NIDEK AFC-230. 848 by 848 pixels. 45 degree fundus photograph. No pharmacologic dilation
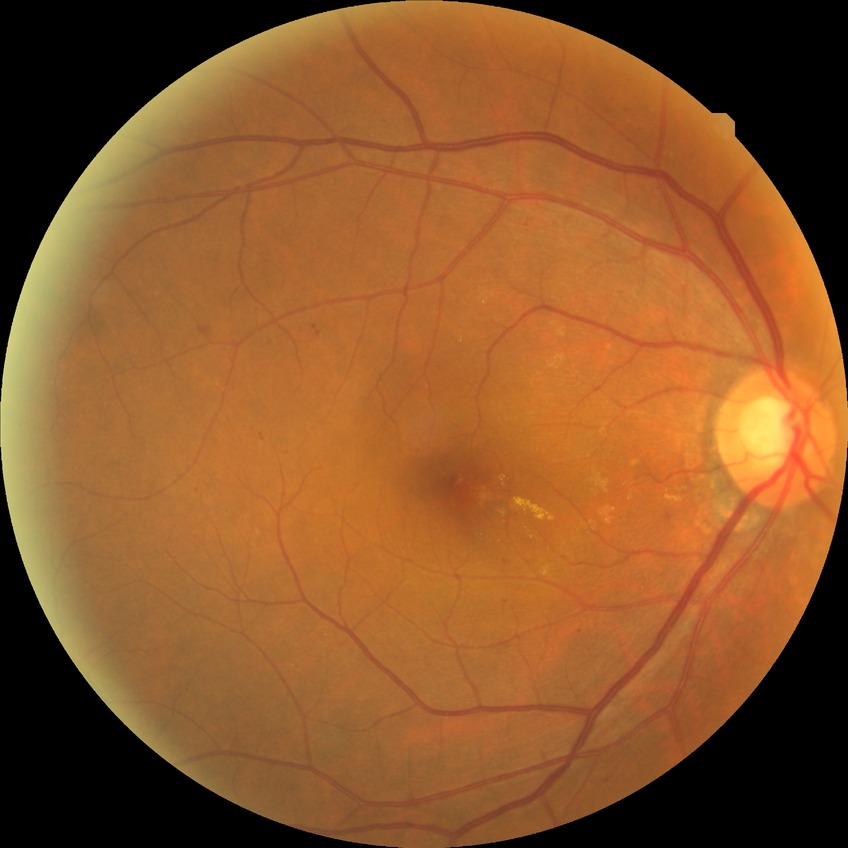
  davis_grade: simple diabetic retinopathy